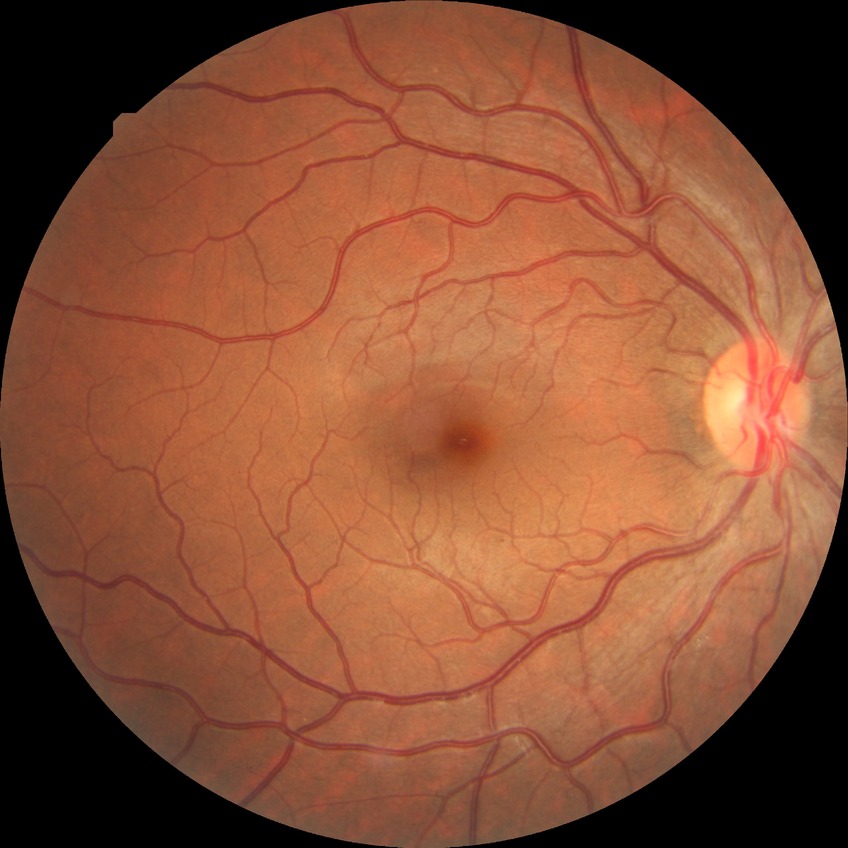

Diabetic retinopathy (DR): NDR (no diabetic retinopathy).